2048x1536; fundus photo: 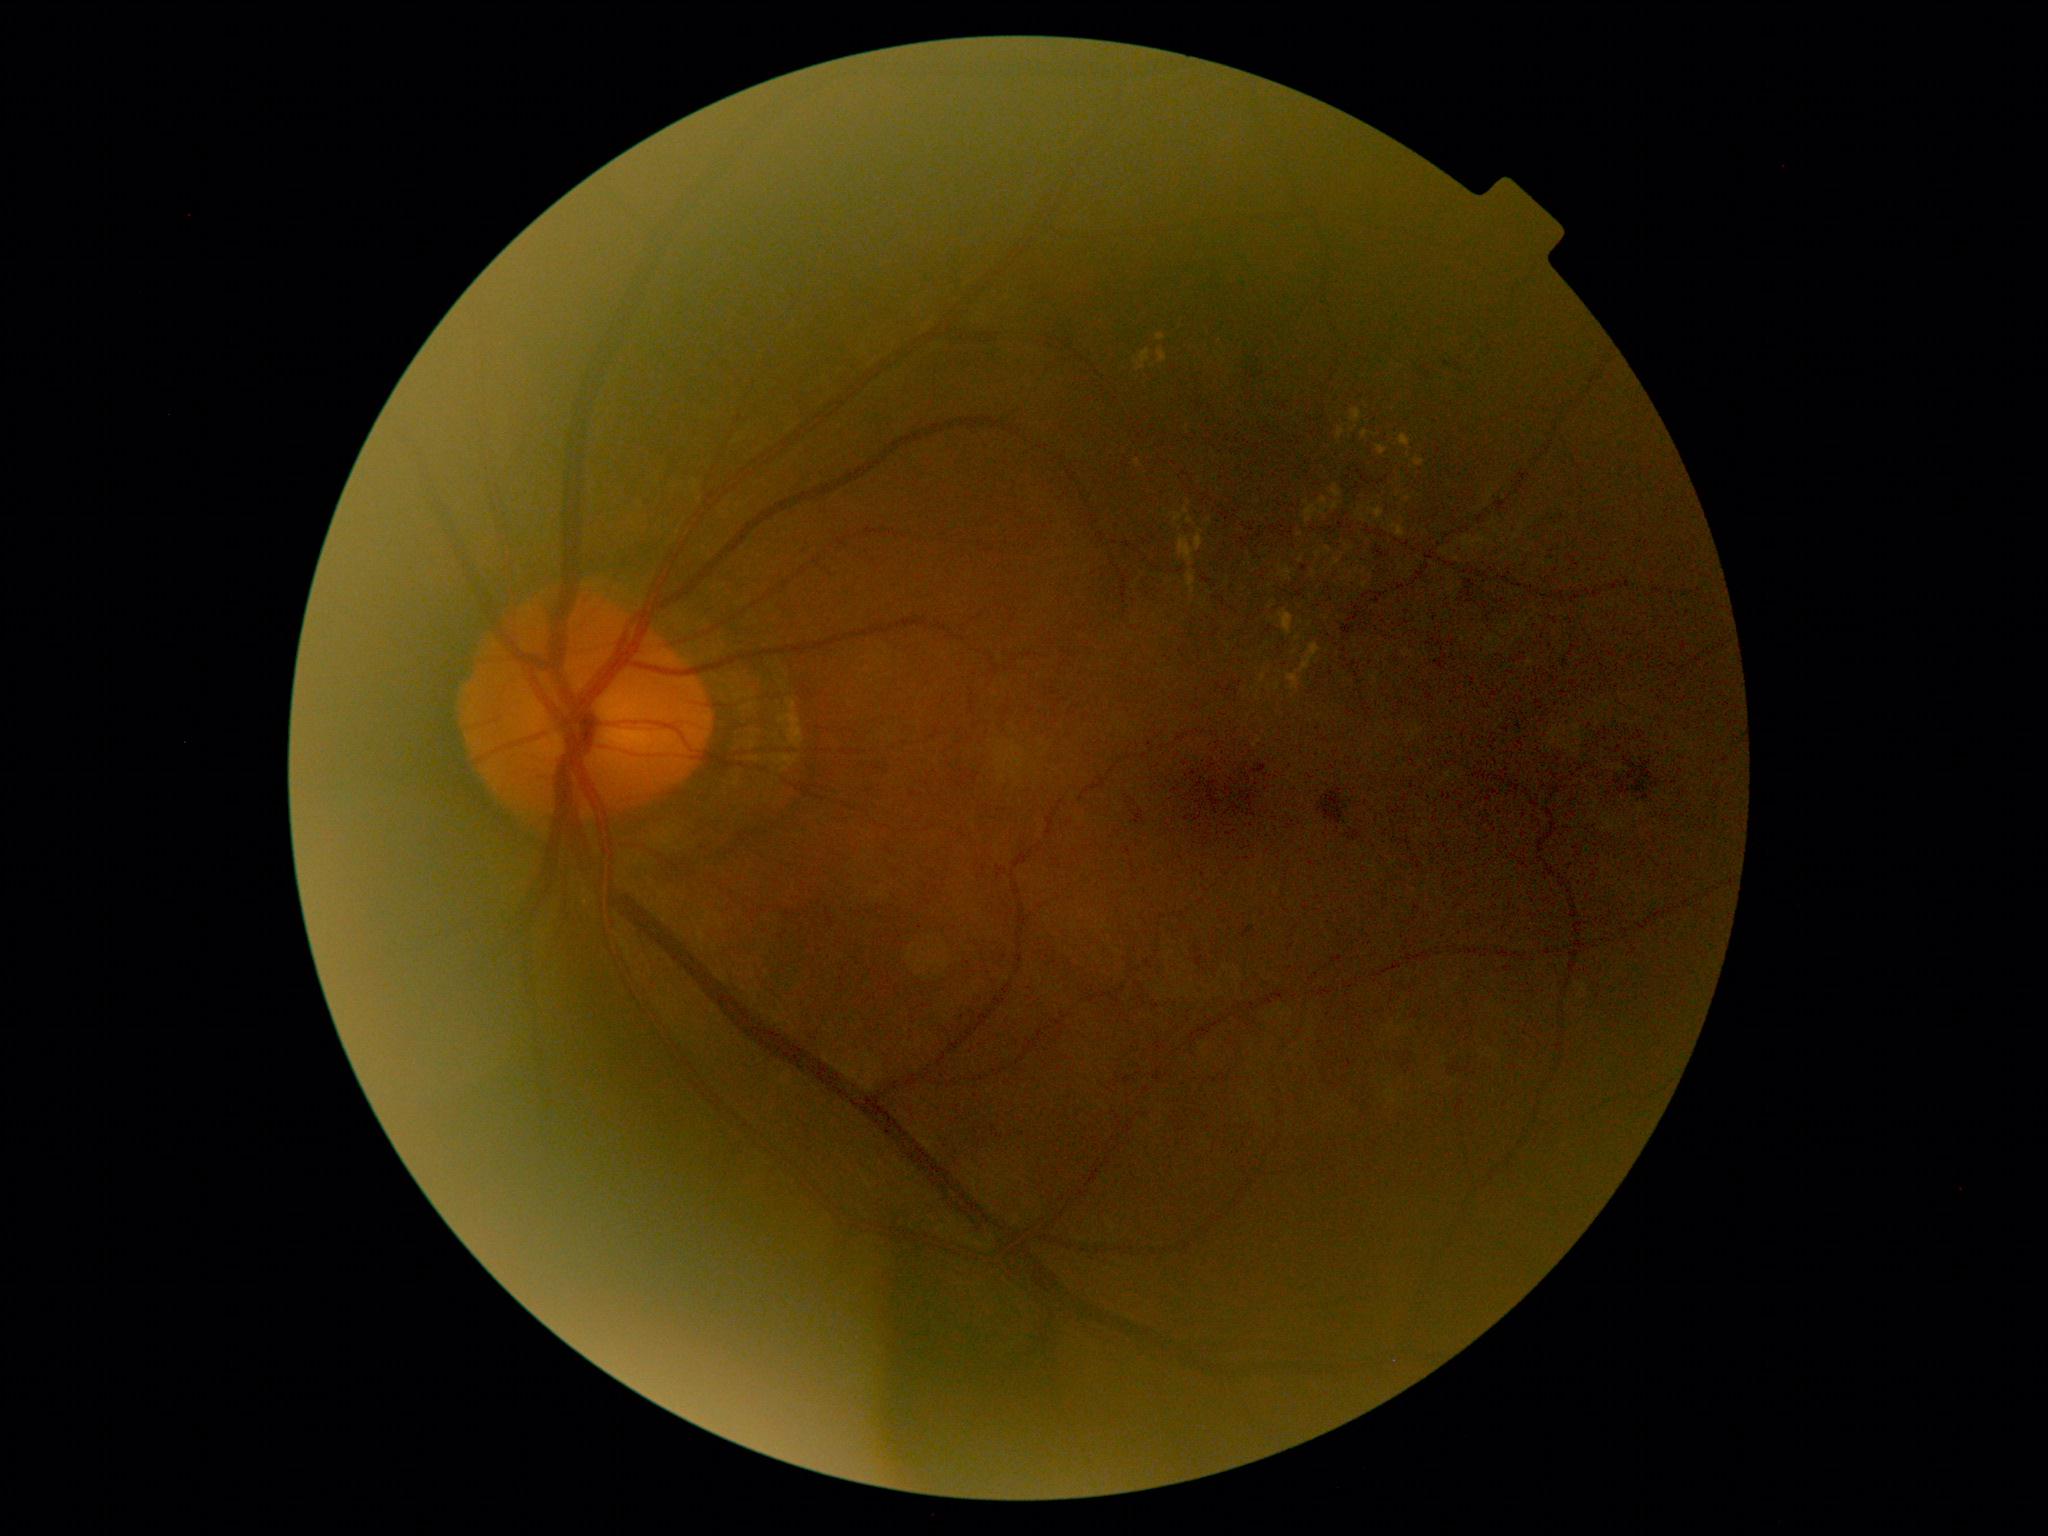
DR severity is moderate NPDR (grade 2).